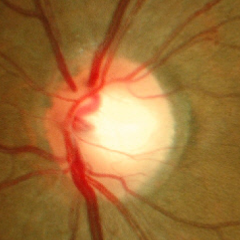 Fundus image with findings of no signs of glaucoma.